45-degree field of view — 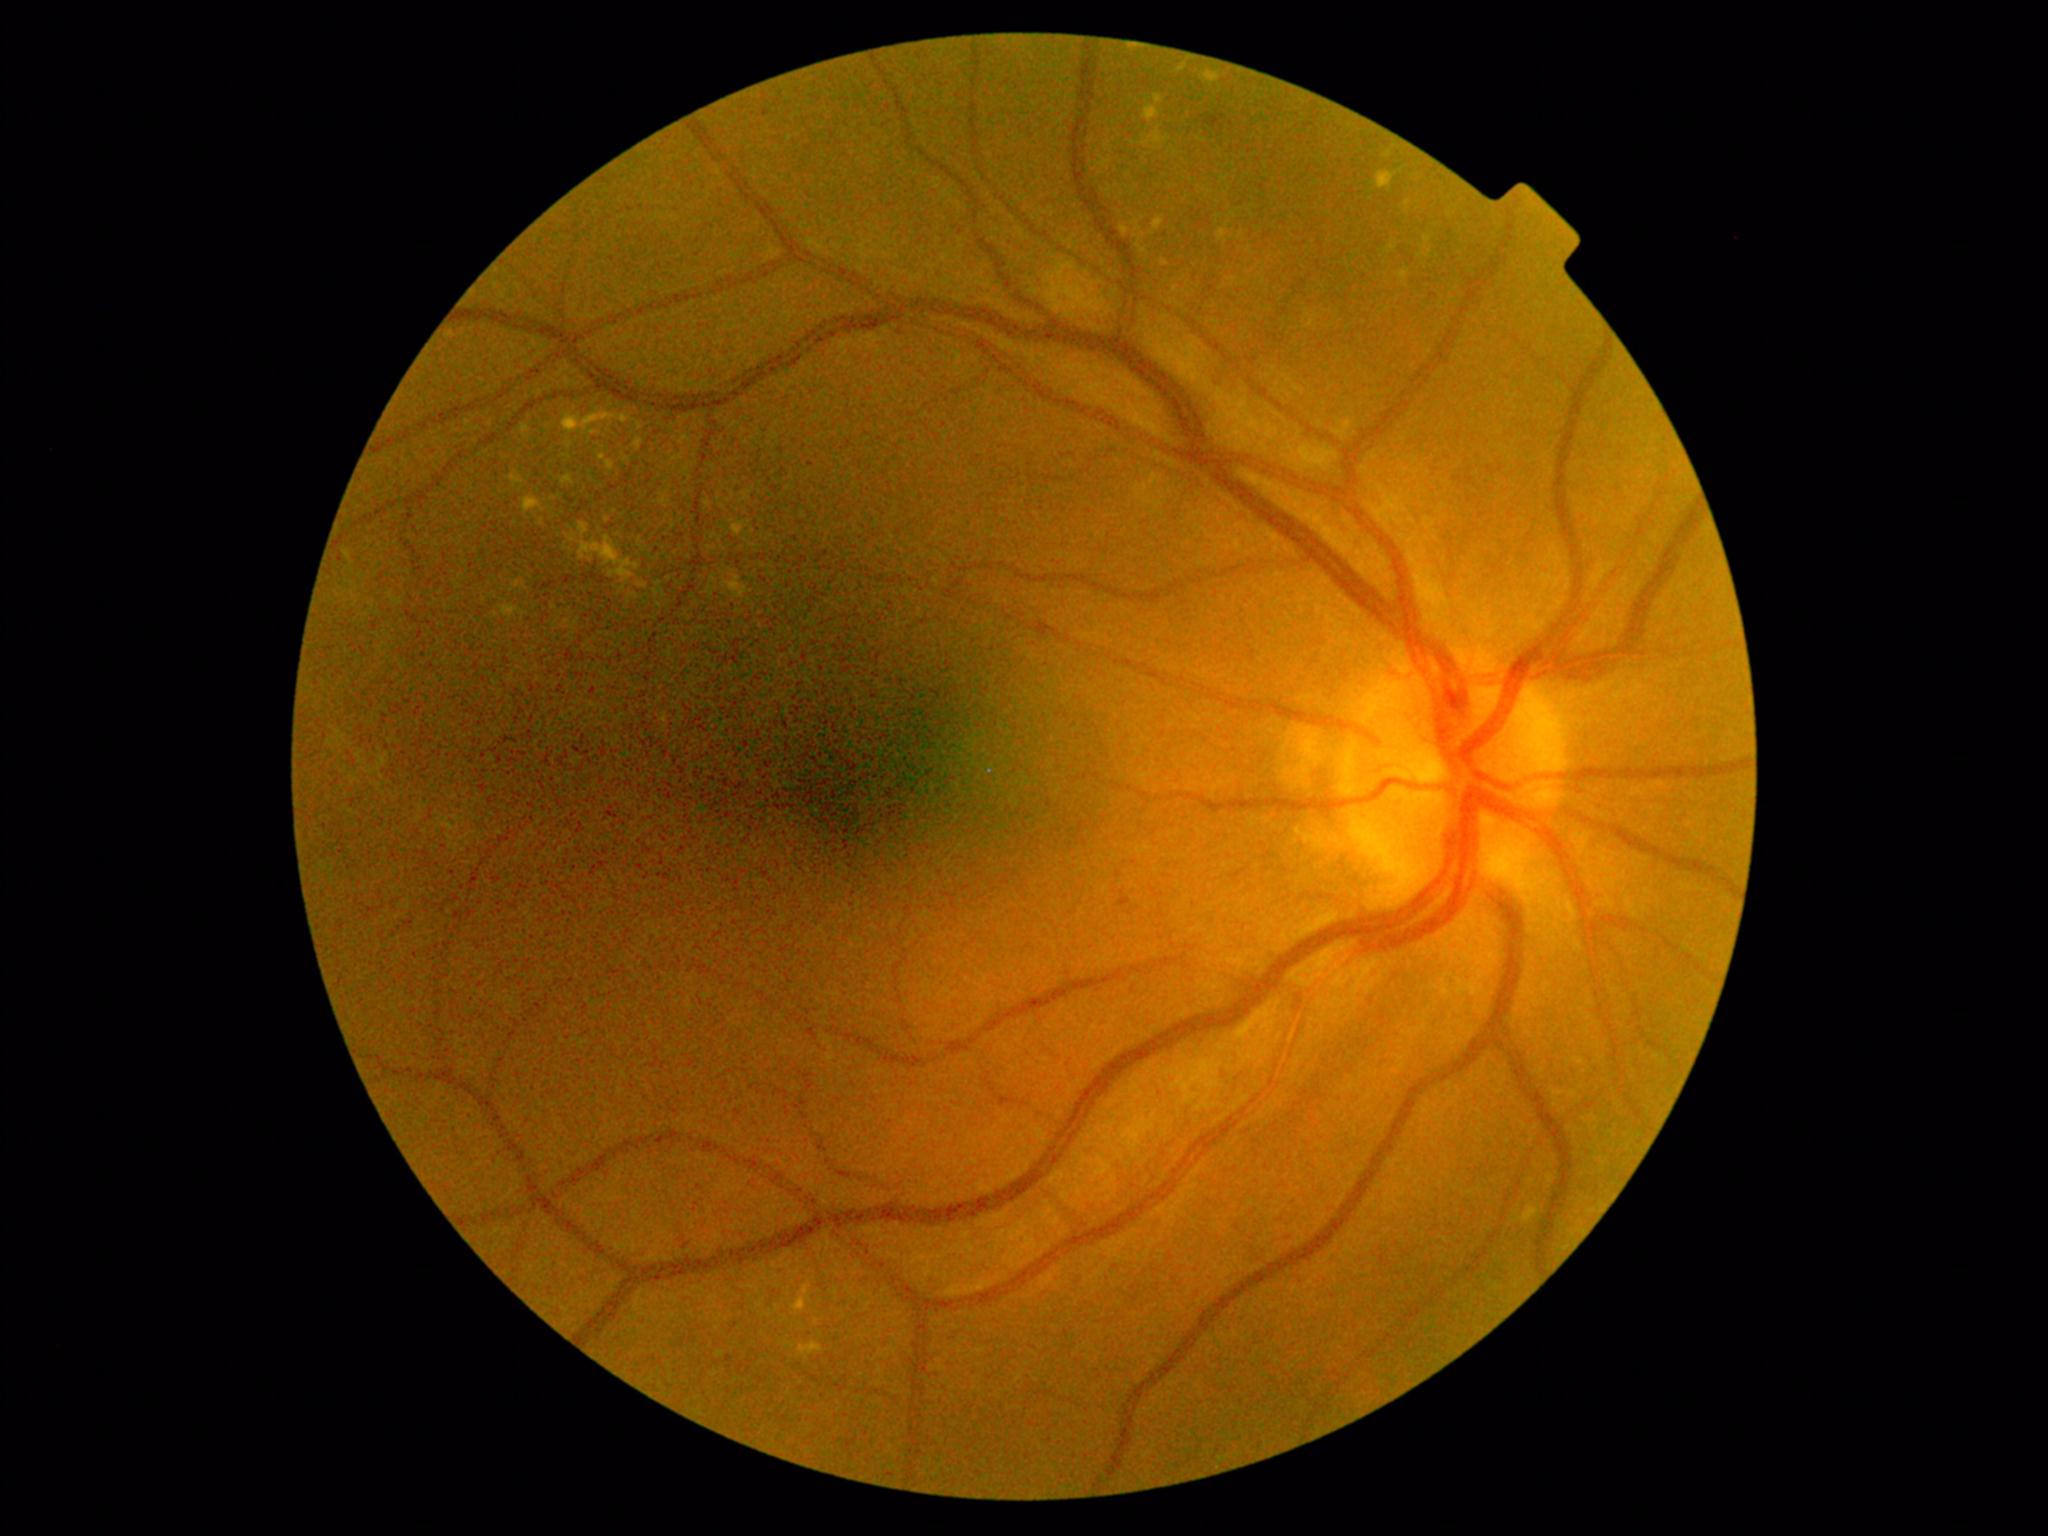

DR grade: 2 (moderate NPDR)
Lesions identified (partial list):
EXs (continued): {"x1": 1143, "y1": 105, "x2": 1160, "y2": 123}; {"x1": 622, "y1": 454, "x2": 631, "y2": 463}; {"x1": 1176, "y1": 63, "x2": 1188, "y2": 73}; {"x1": 721, "y1": 569, "x2": 753, "y2": 599}; {"x1": 1397, "y1": 268, "x2": 1410, "y2": 281}; {"x1": 499, "y1": 605, "x2": 529, "y2": 622}; {"x1": 566, "y1": 440, "x2": 574, "y2": 449}; {"x1": 1376, "y1": 171, "x2": 1398, "y2": 189}; {"x1": 1152, "y1": 218, "x2": 1165, "y2": 235}; {"x1": 1386, "y1": 242, "x2": 1398, "y2": 254}
Additional small EXs near (551, 510); (1389, 155); (607, 520); (506, 458)